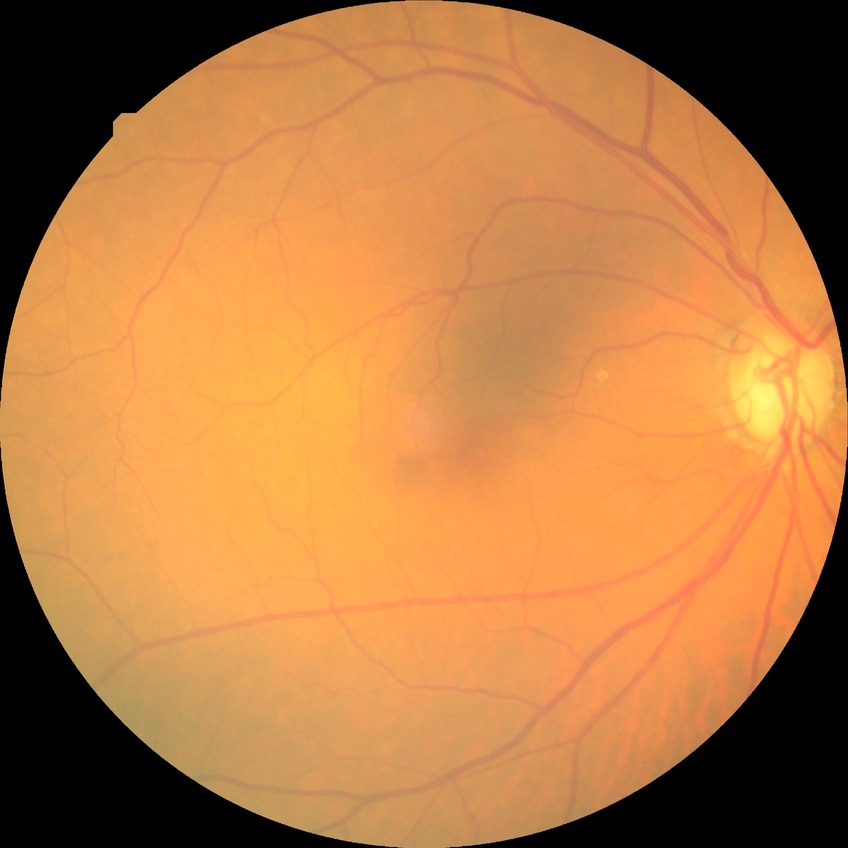
diabetic retinopathy (DR): NDR (no diabetic retinopathy).